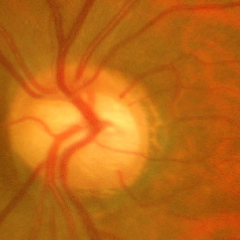

Findings consistent with glaucoma.
Advanced glaucoma.
Diagnostic criteria: near-total cupping of the optic nerve head, with or without severe visual field loss within the central 10 degrees of fixation.